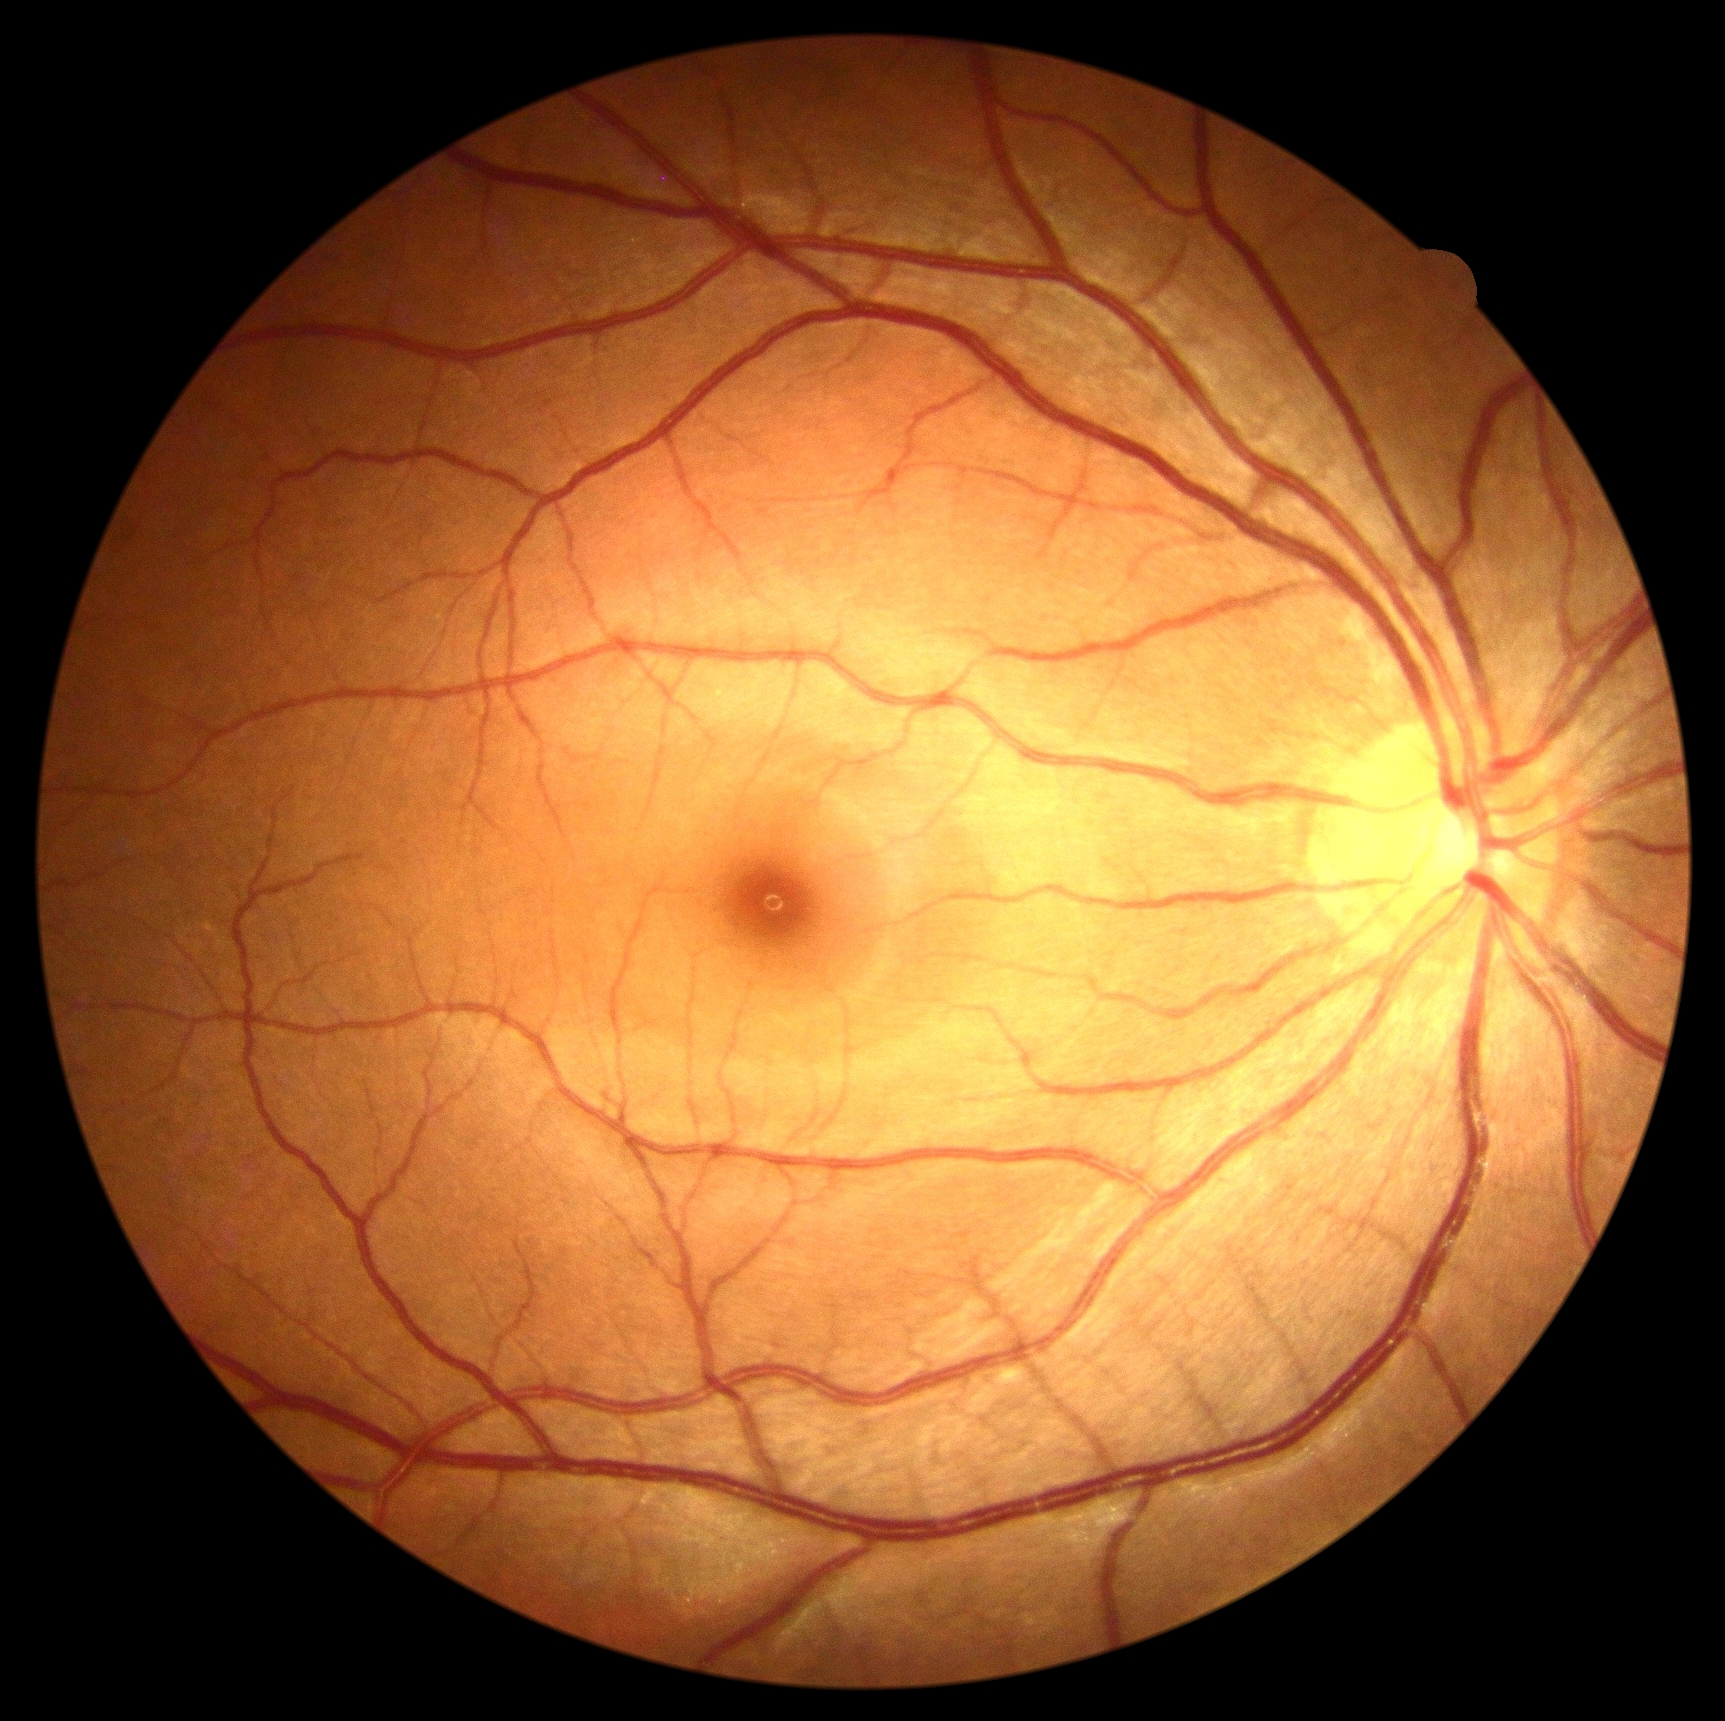 DR severity is grade 0 (no apparent retinopathy).